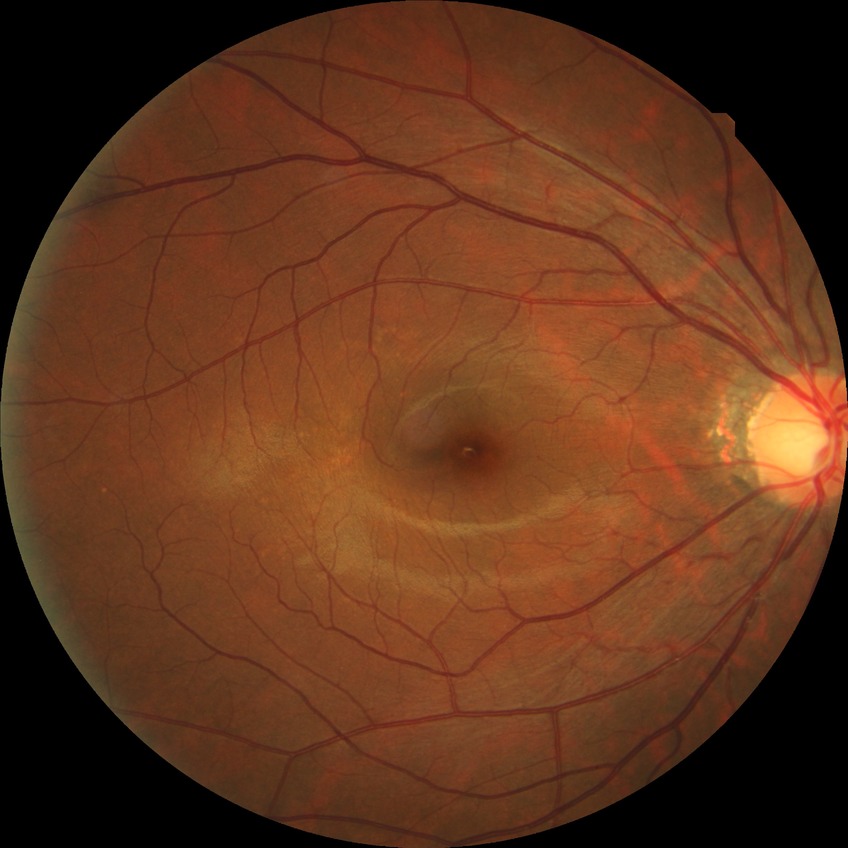
Modified Davis classification: no diabetic retinopathy.